2352 by 1568 pixels
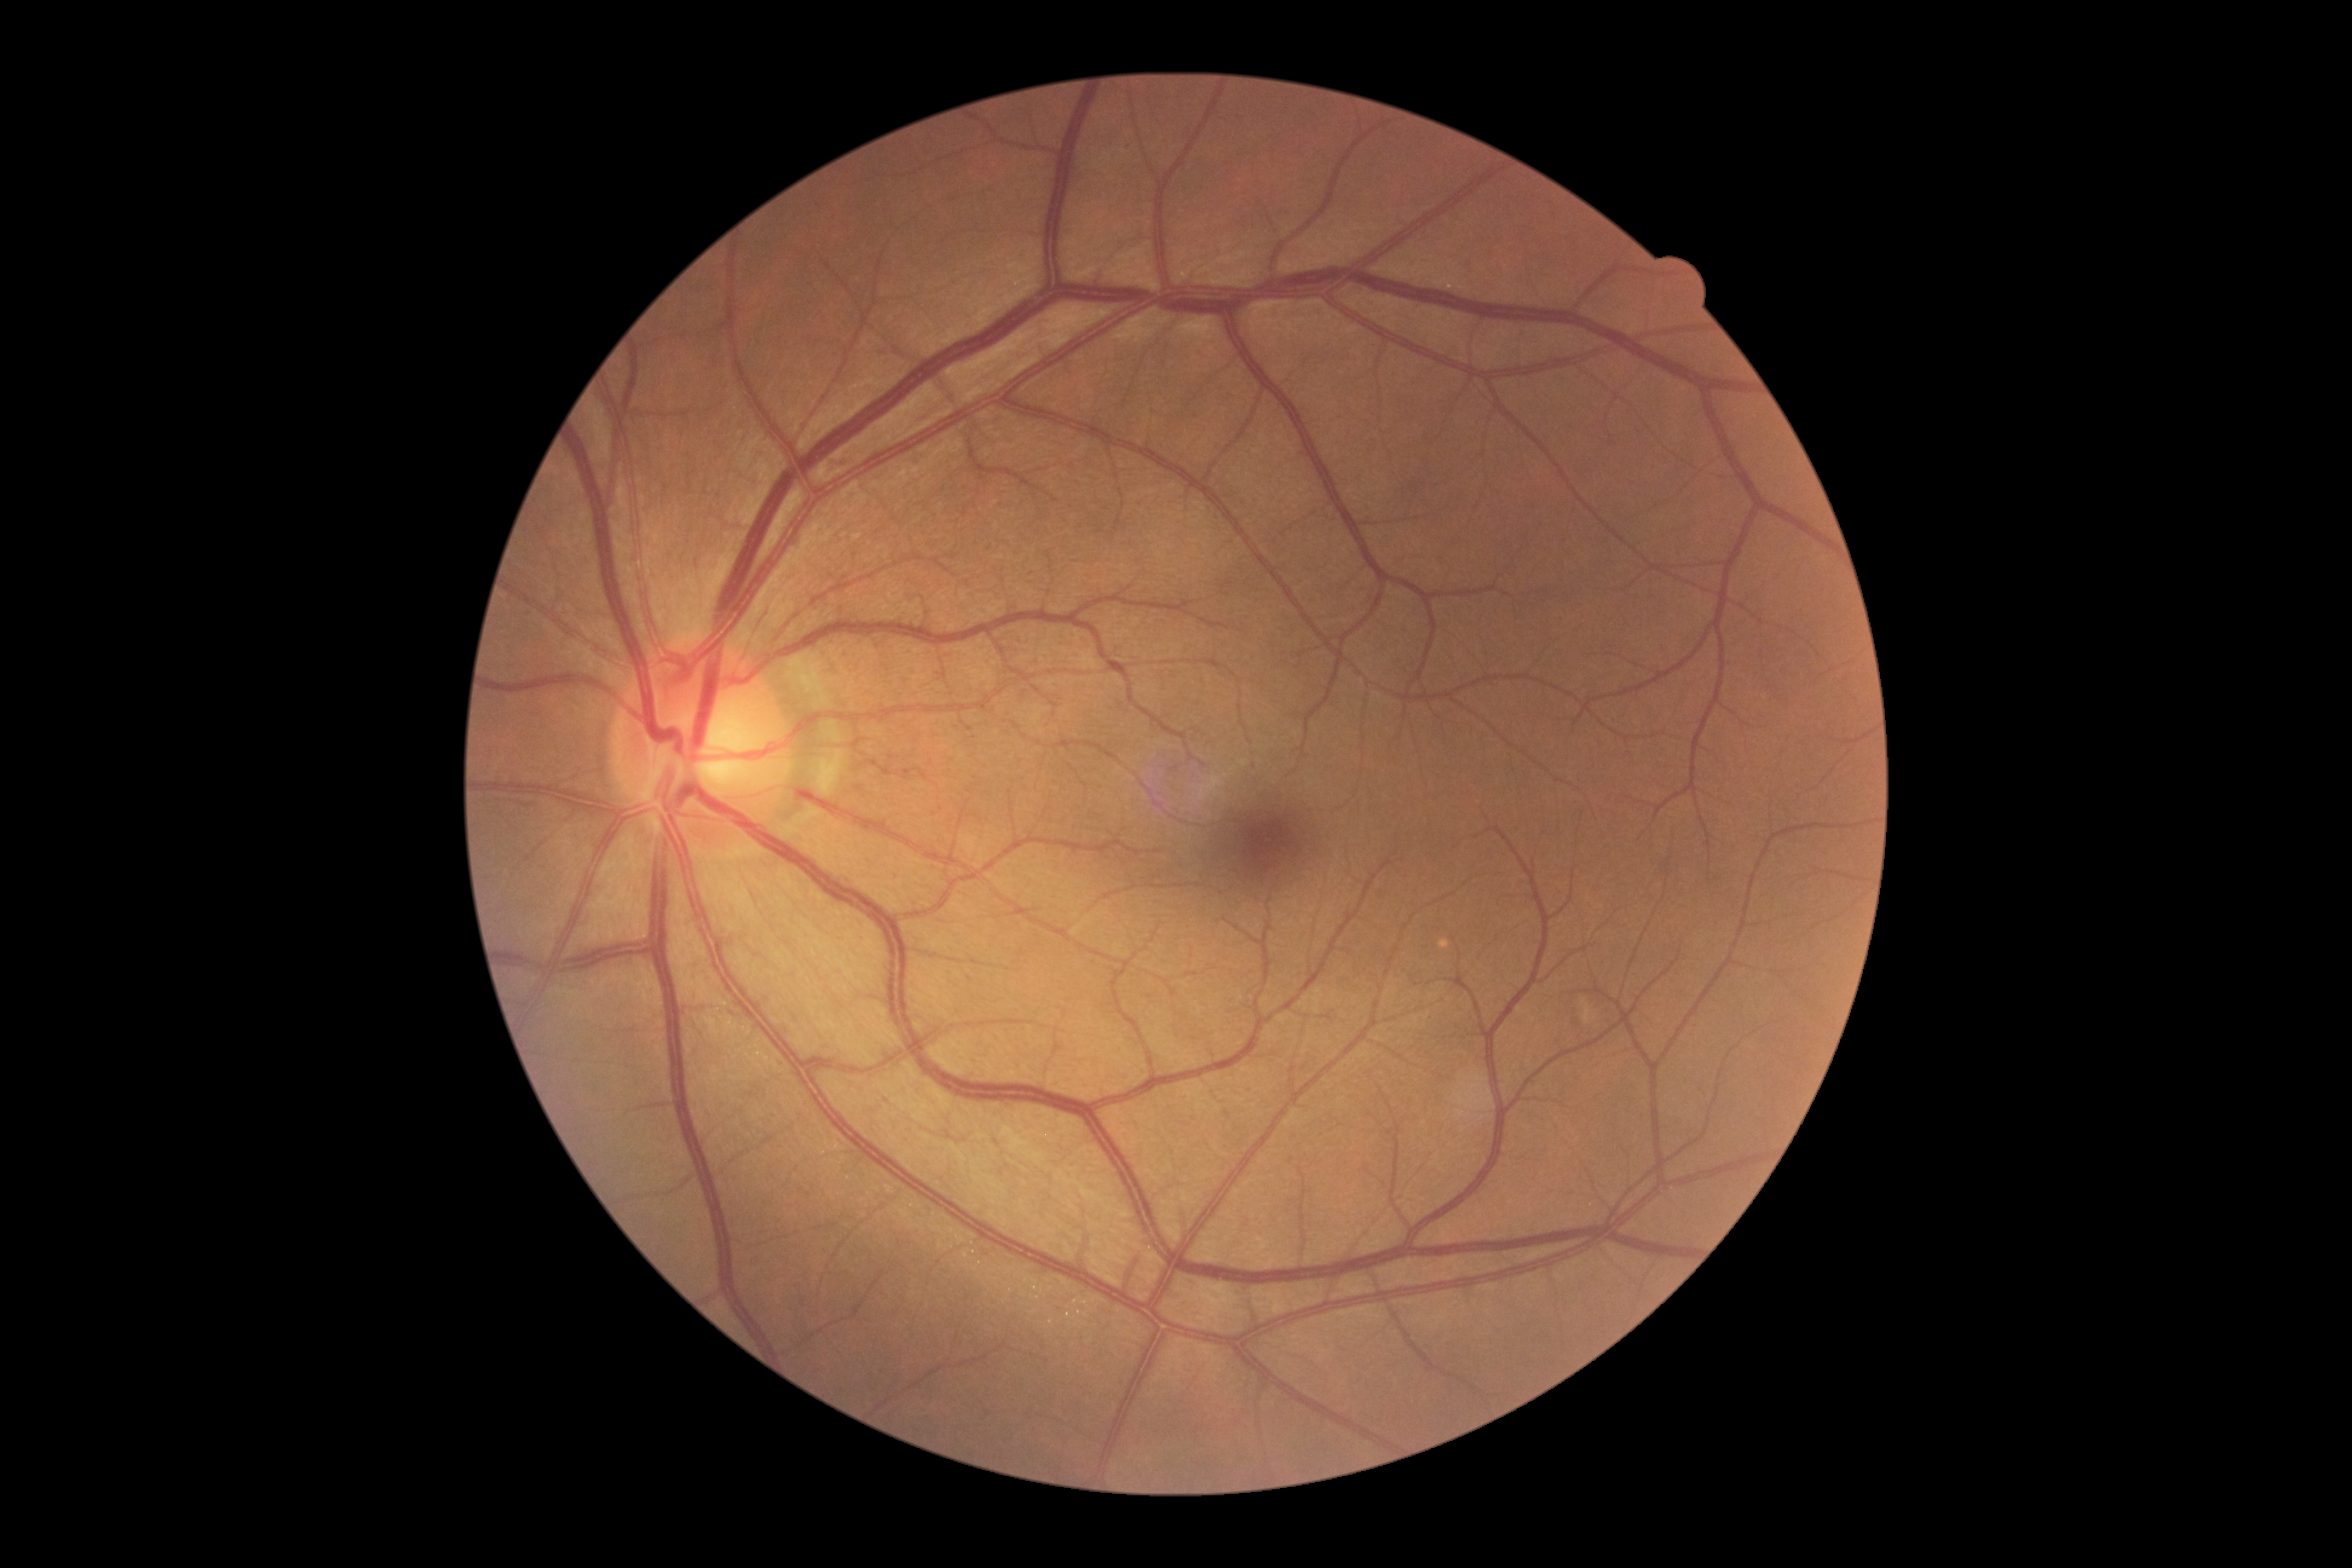
DR grade is 0.
No apparent diabetic retinopathy.